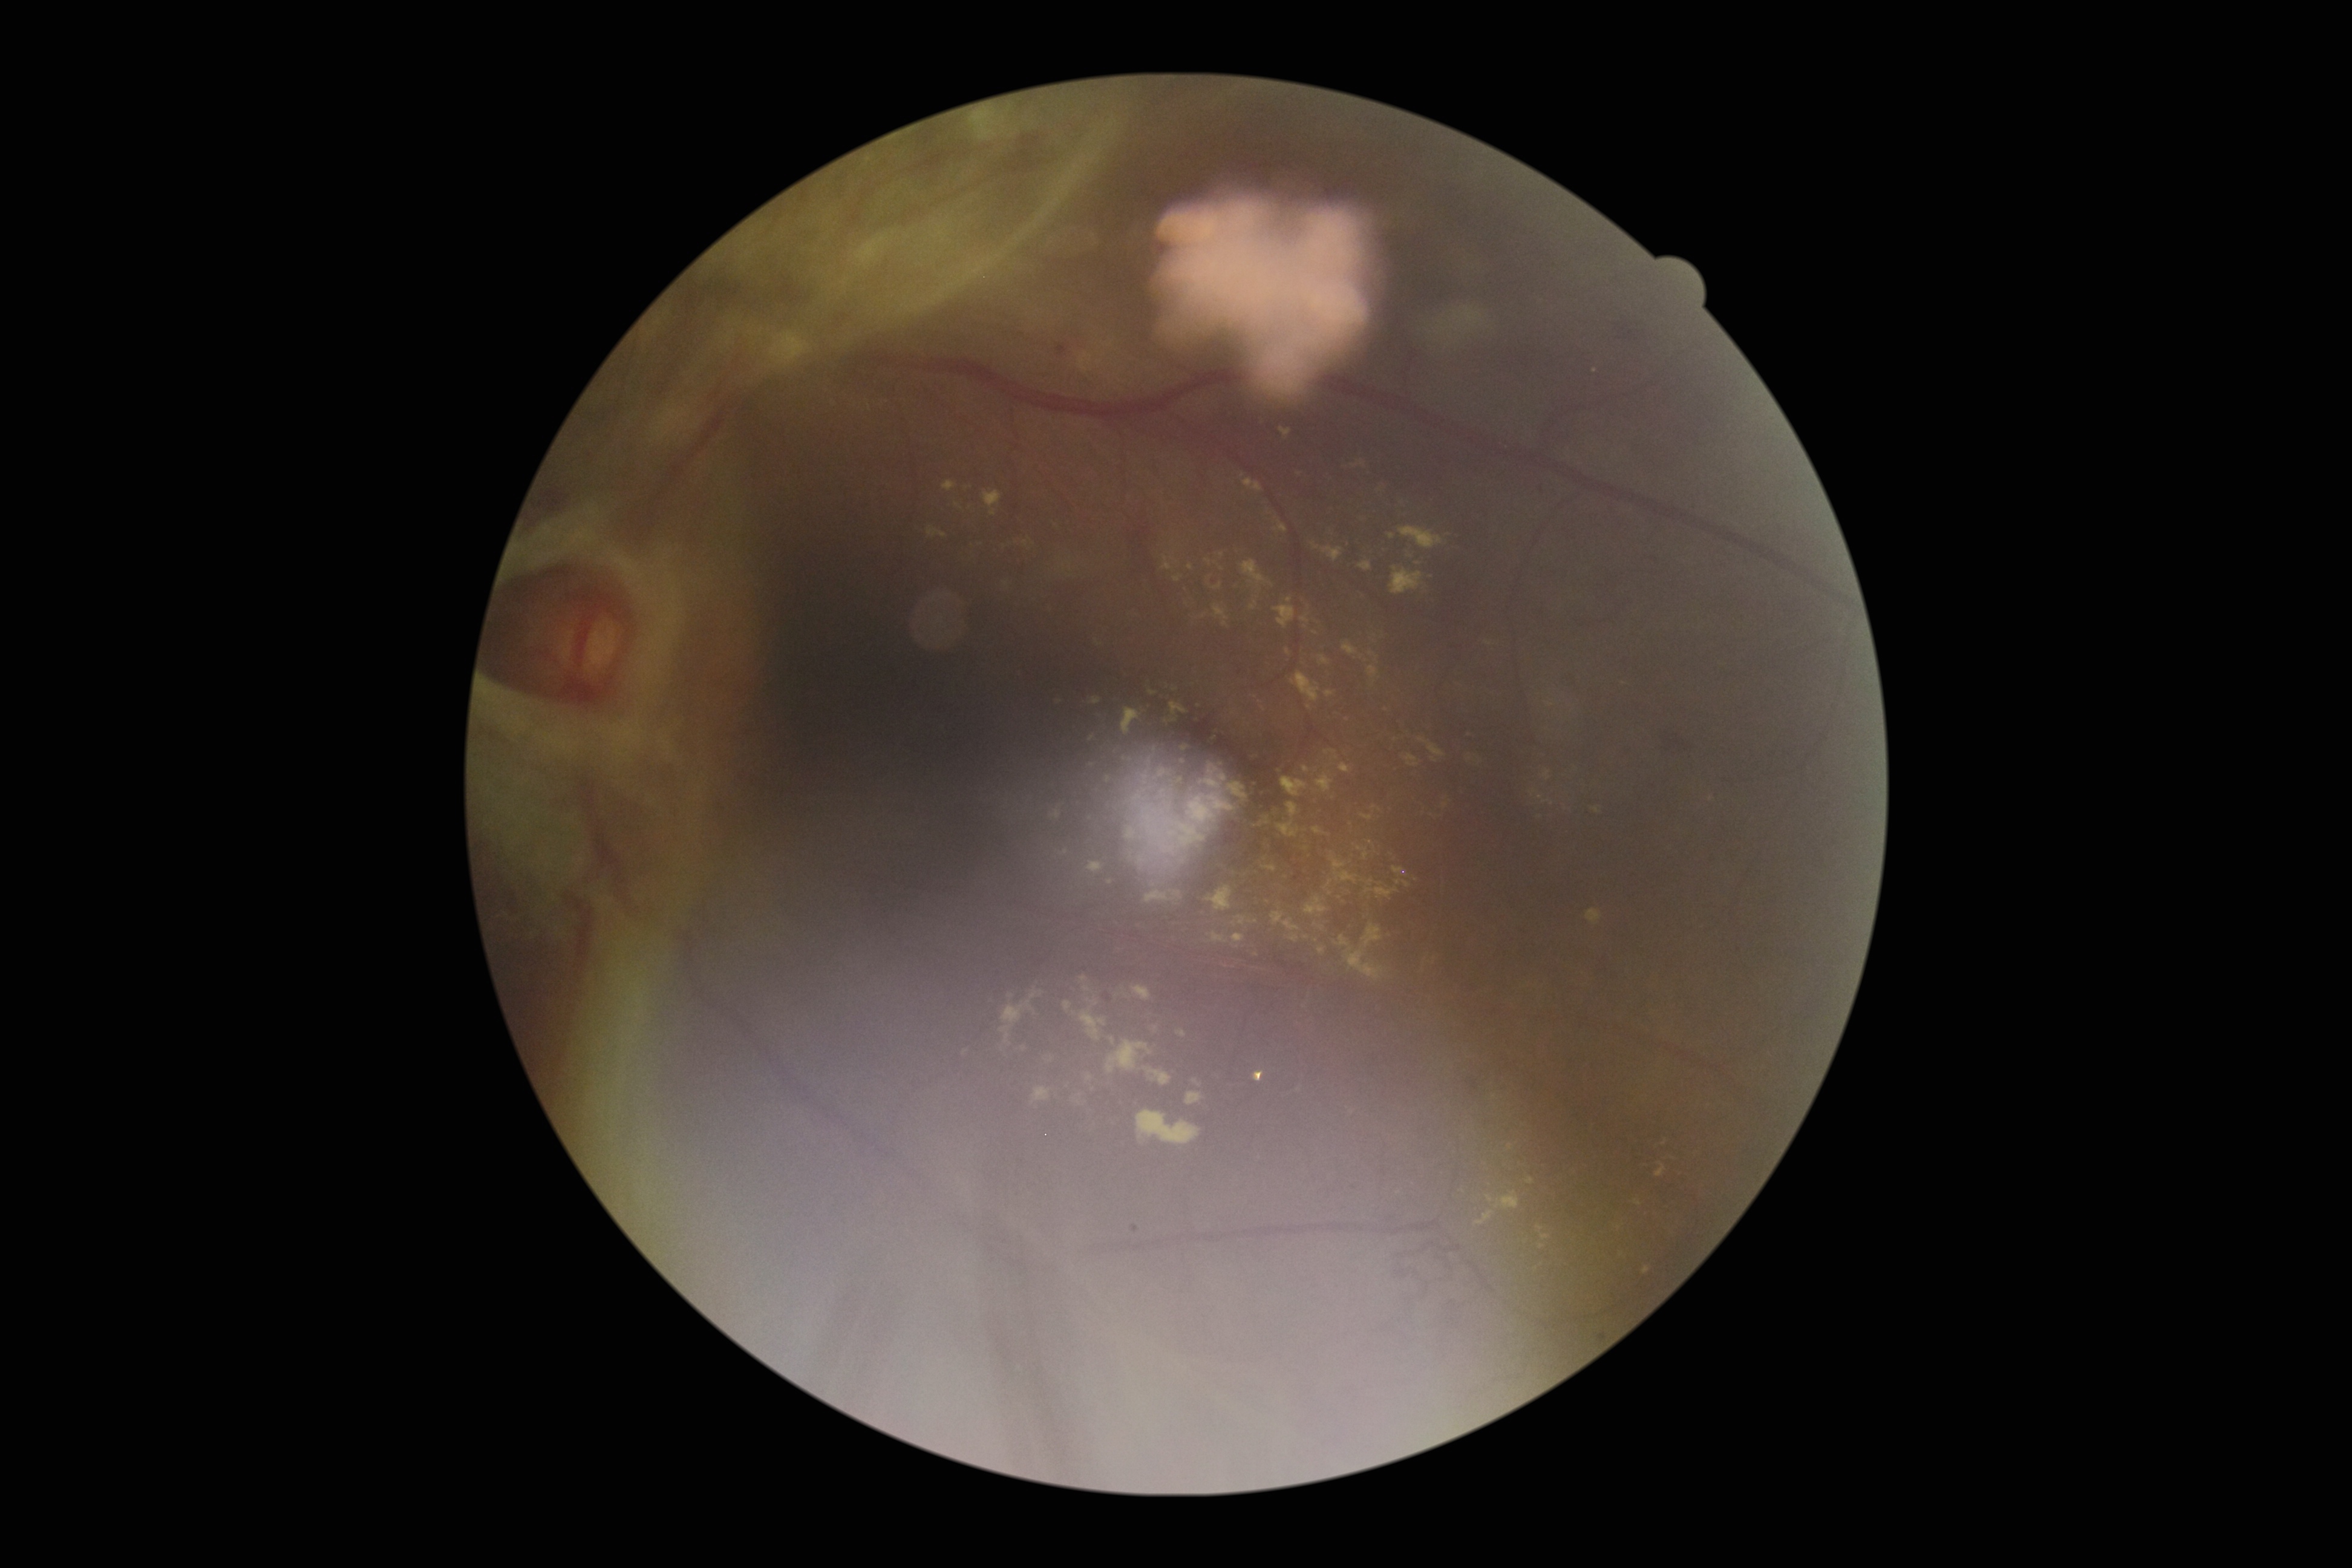

partial: true
dr_grade: 4
lesions:
  ex:
    - 1329,878,1348,904
    - 1248,752,1259,762
    - 1056,848,1068,857
    - 1327,534,1346,543
    - 1103,873,1116,895
    - 1411,733,1444,760
    - 1339,764,1359,783
    - 1194,1075,1202,1092
    - 1002,988,1047,1054
    - 1195,716,1200,724
    - 1253,783,1261,789
    - 1184,590,1206,619
    - 1277,760,1293,775
    - 1542,770,1550,780
    - 1252,695,1270,714
    - 1315,916,1330,930
  ex_small_centers:
    - {"x": 1222, "y": 555}
    - {"x": 1665, "y": 1143}